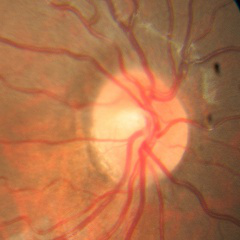
No evidence of glaucoma.